2346x1568px: 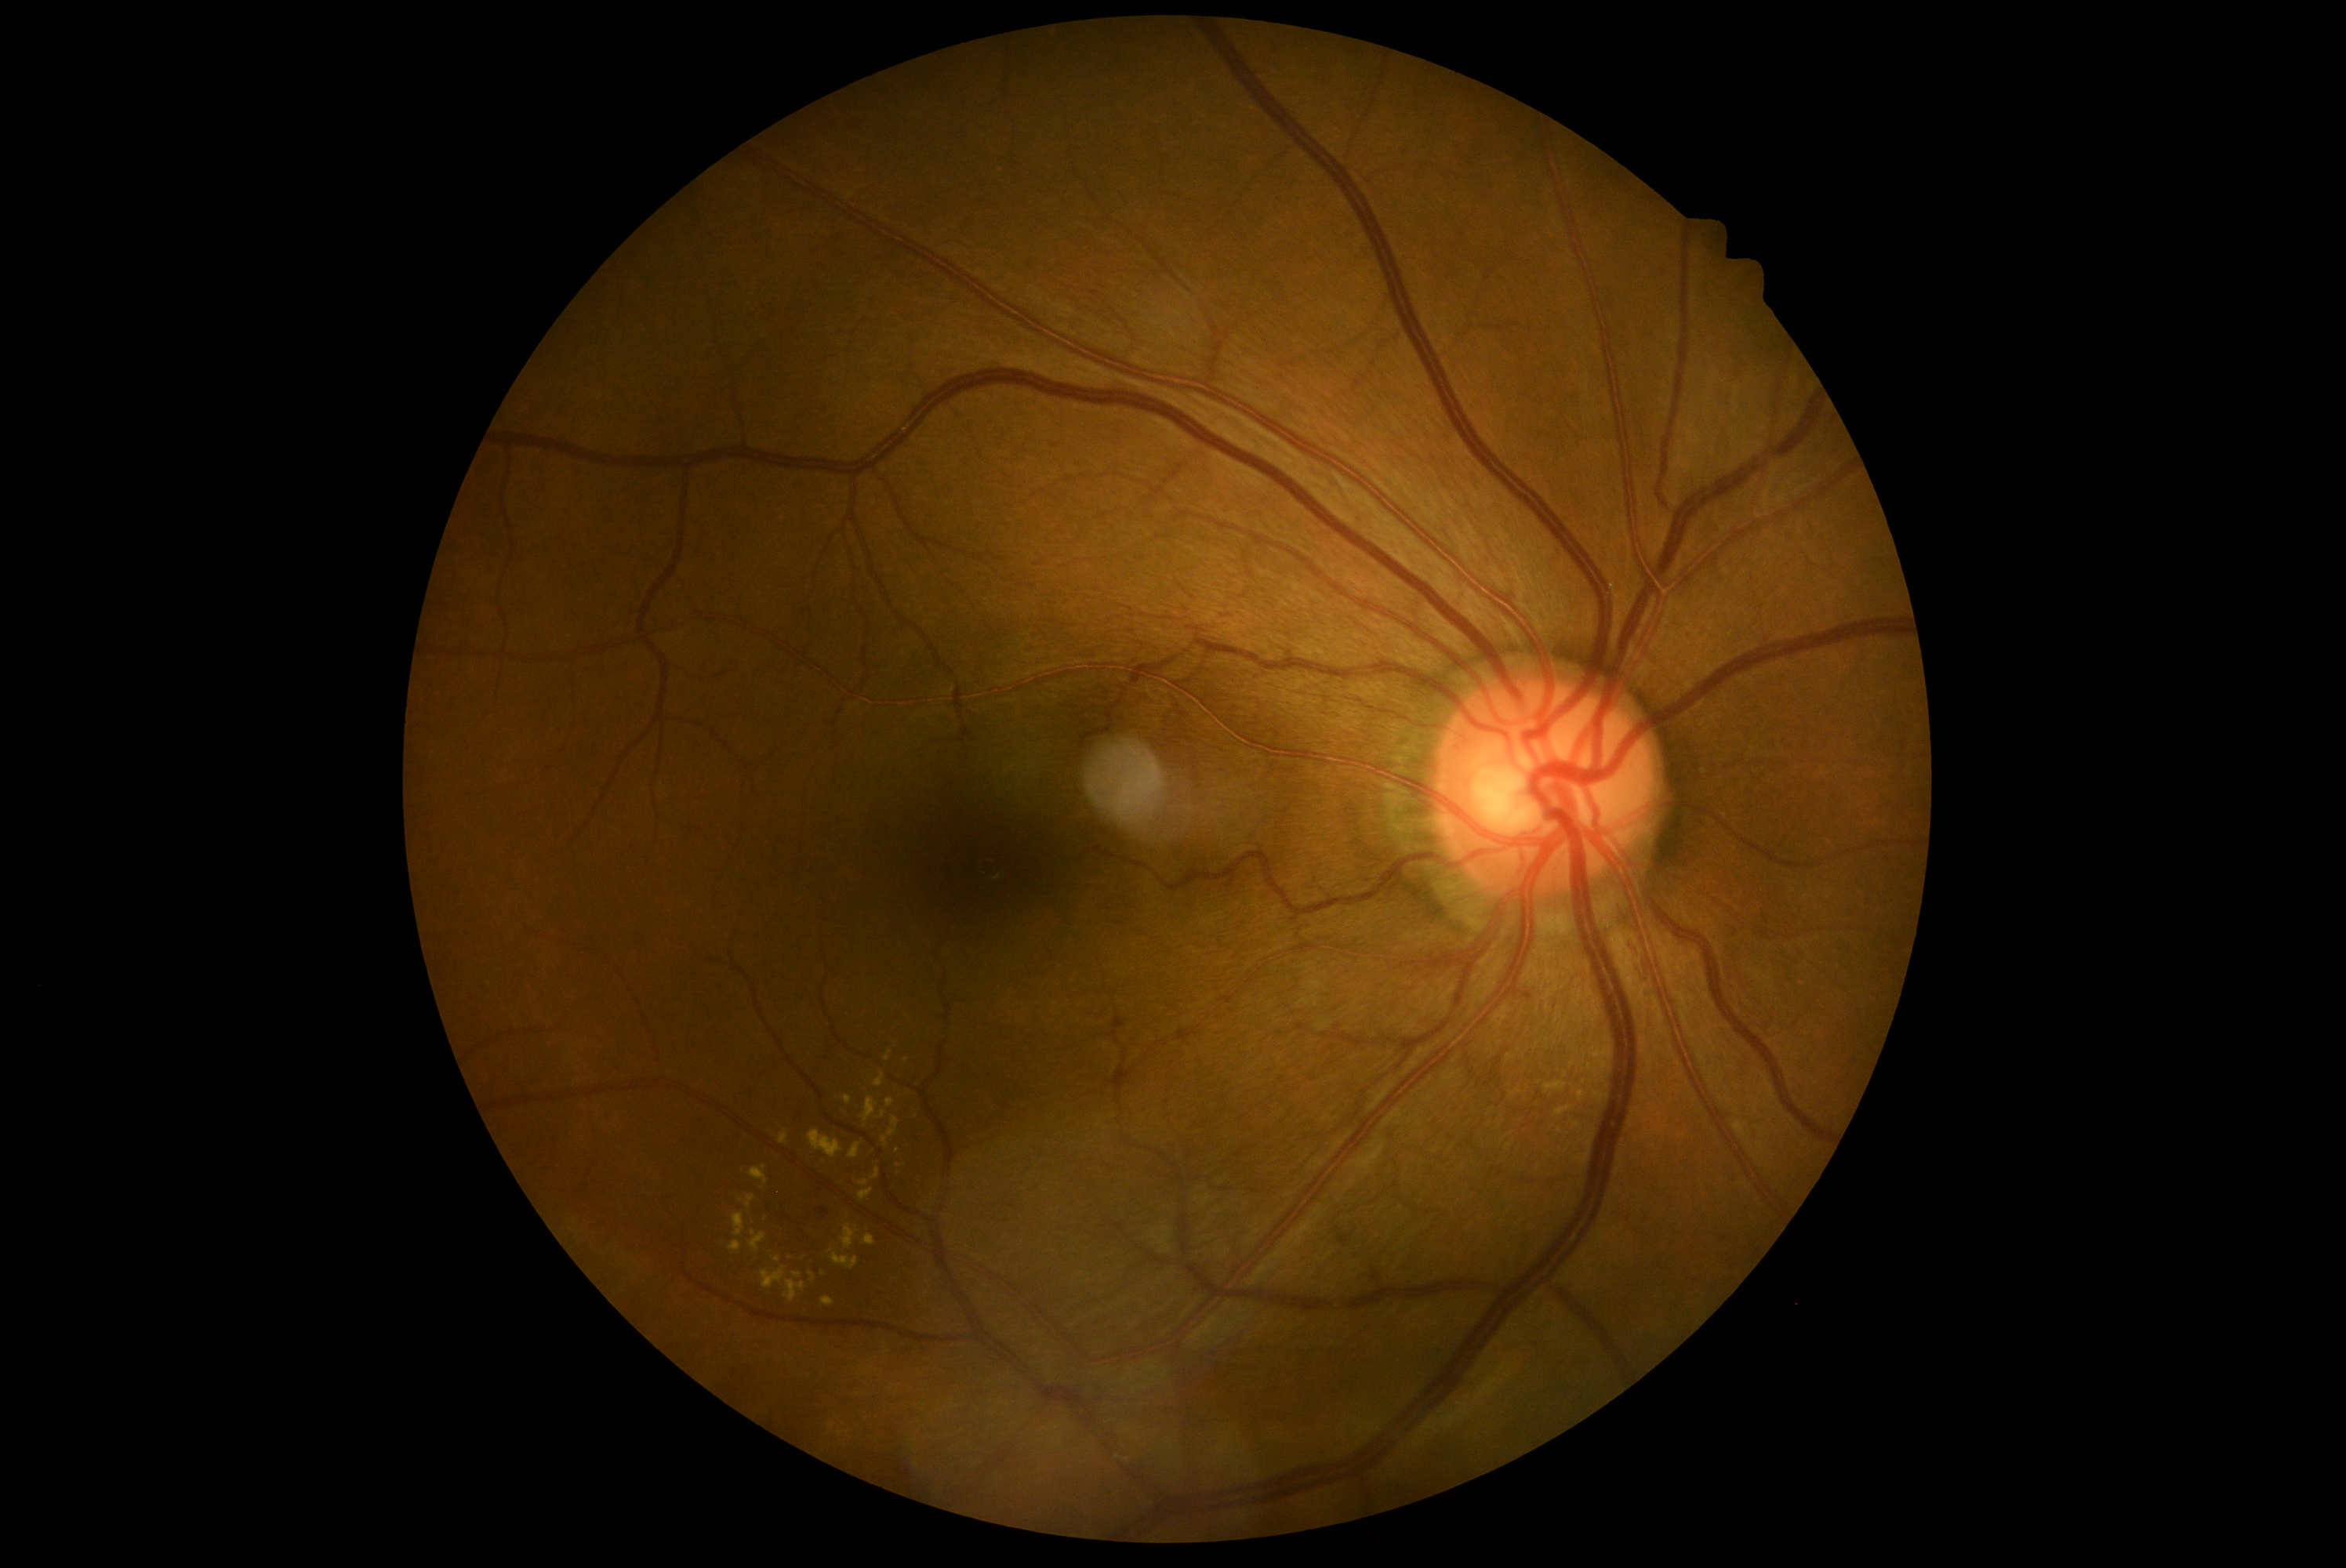

dr_grade: 2 (moderate NPDR)
dr_category: non-proliferative diabetic retinopathy